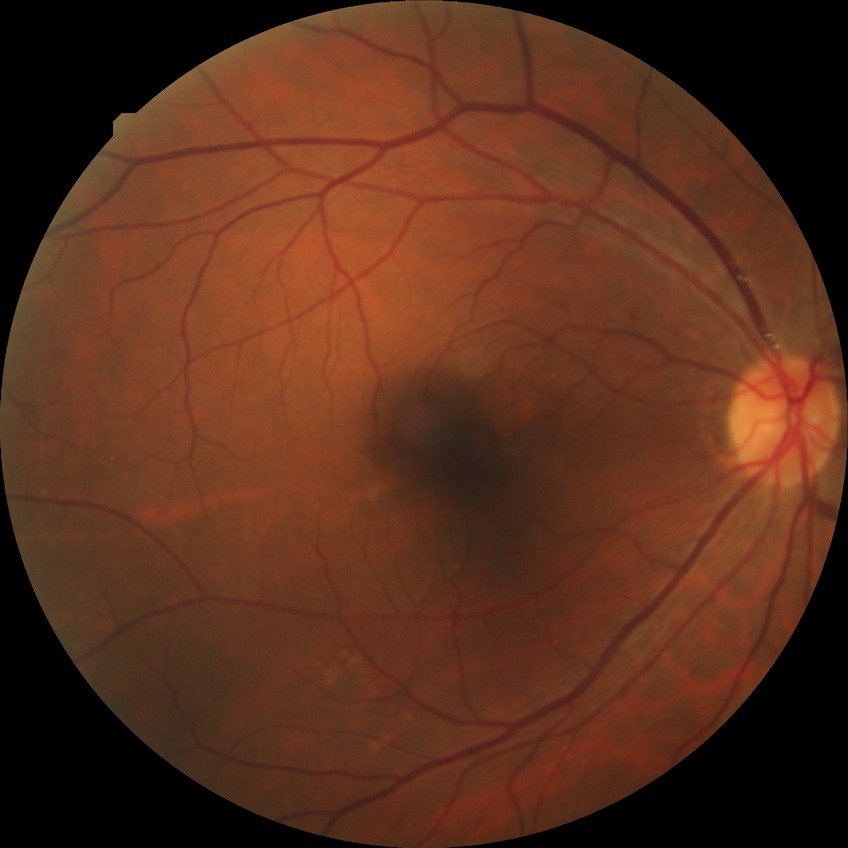
Diabetic retinopathy grade: no diabetic retinopathy.